Color fundus image, no pharmacologic dilation — 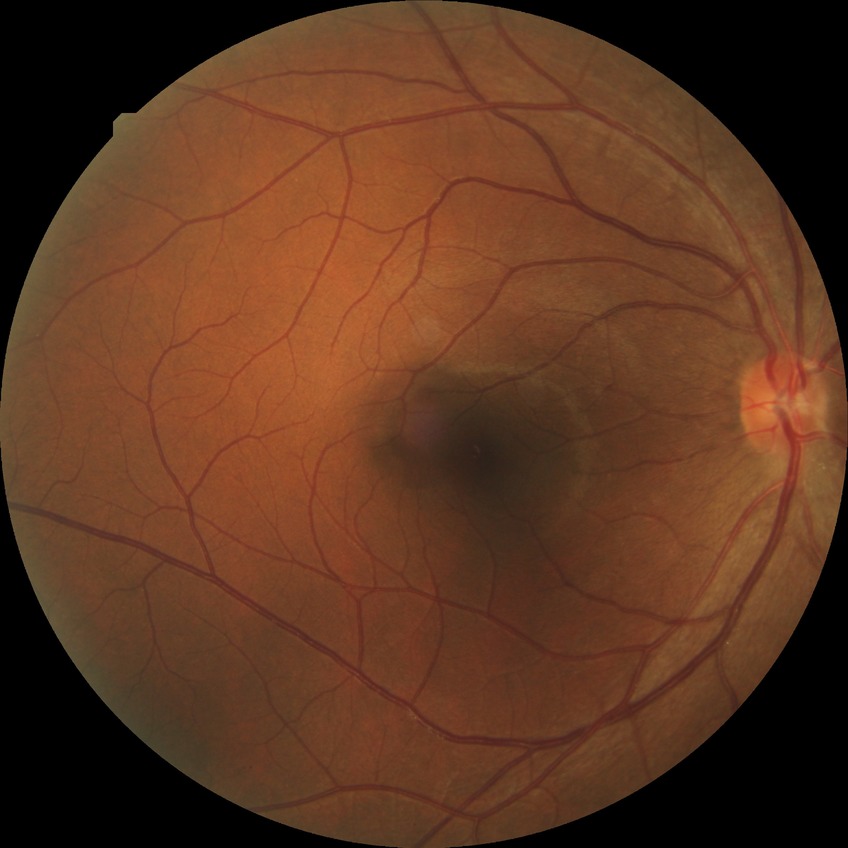
Diabetic retinopathy (DR) is no diabetic retinopathy (NDR).